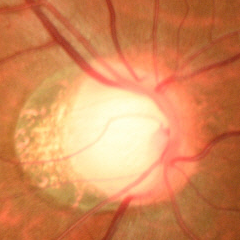 Glaucoma is present. Glaucoma diagnosis: early-stage glaucoma.